35° field of view before cropping · optic nerve head photograph · acquired with a Topcon TRC:
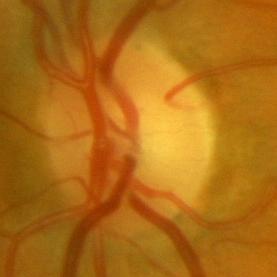

The image shows no glaucomatous optic neuropathy.